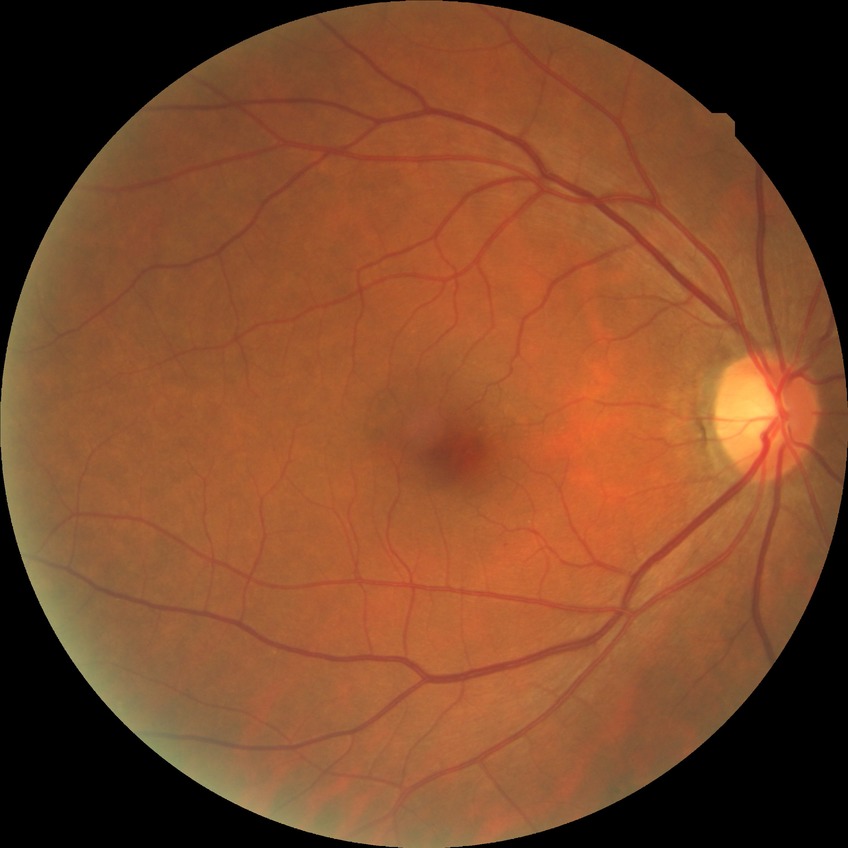
Diabetic retinopathy (DR): no diabetic retinopathy (NDR).